Nonmydriatic fundus photograph — 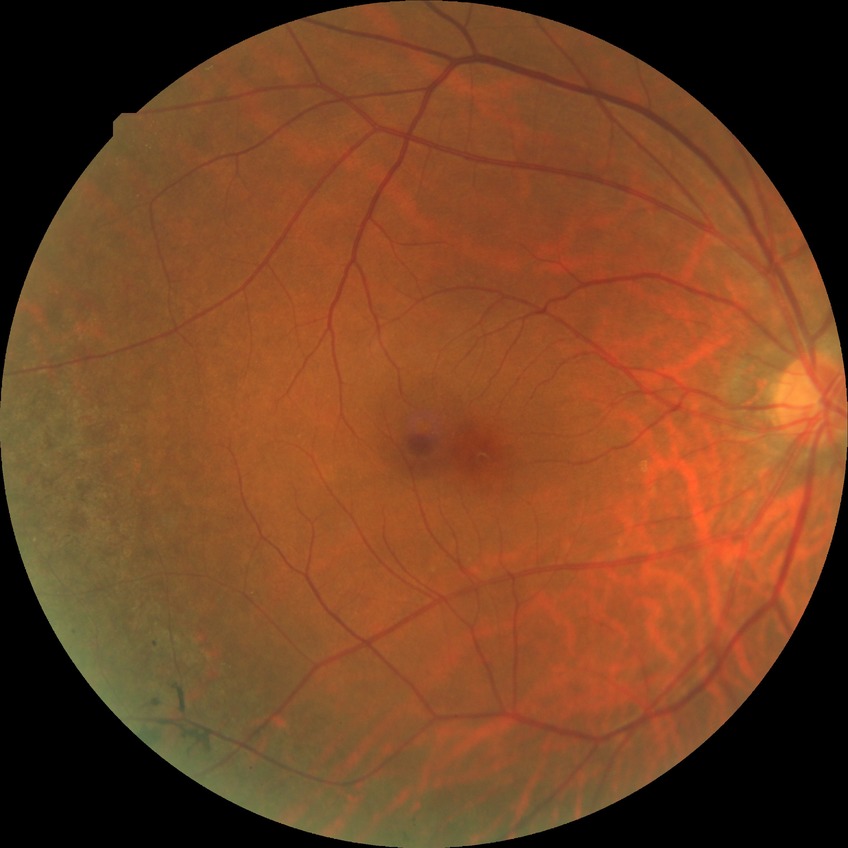 diabetic retinopathy (DR): no diabetic retinopathy (NDR).